Image size 2089x1764. Color fundus photograph: 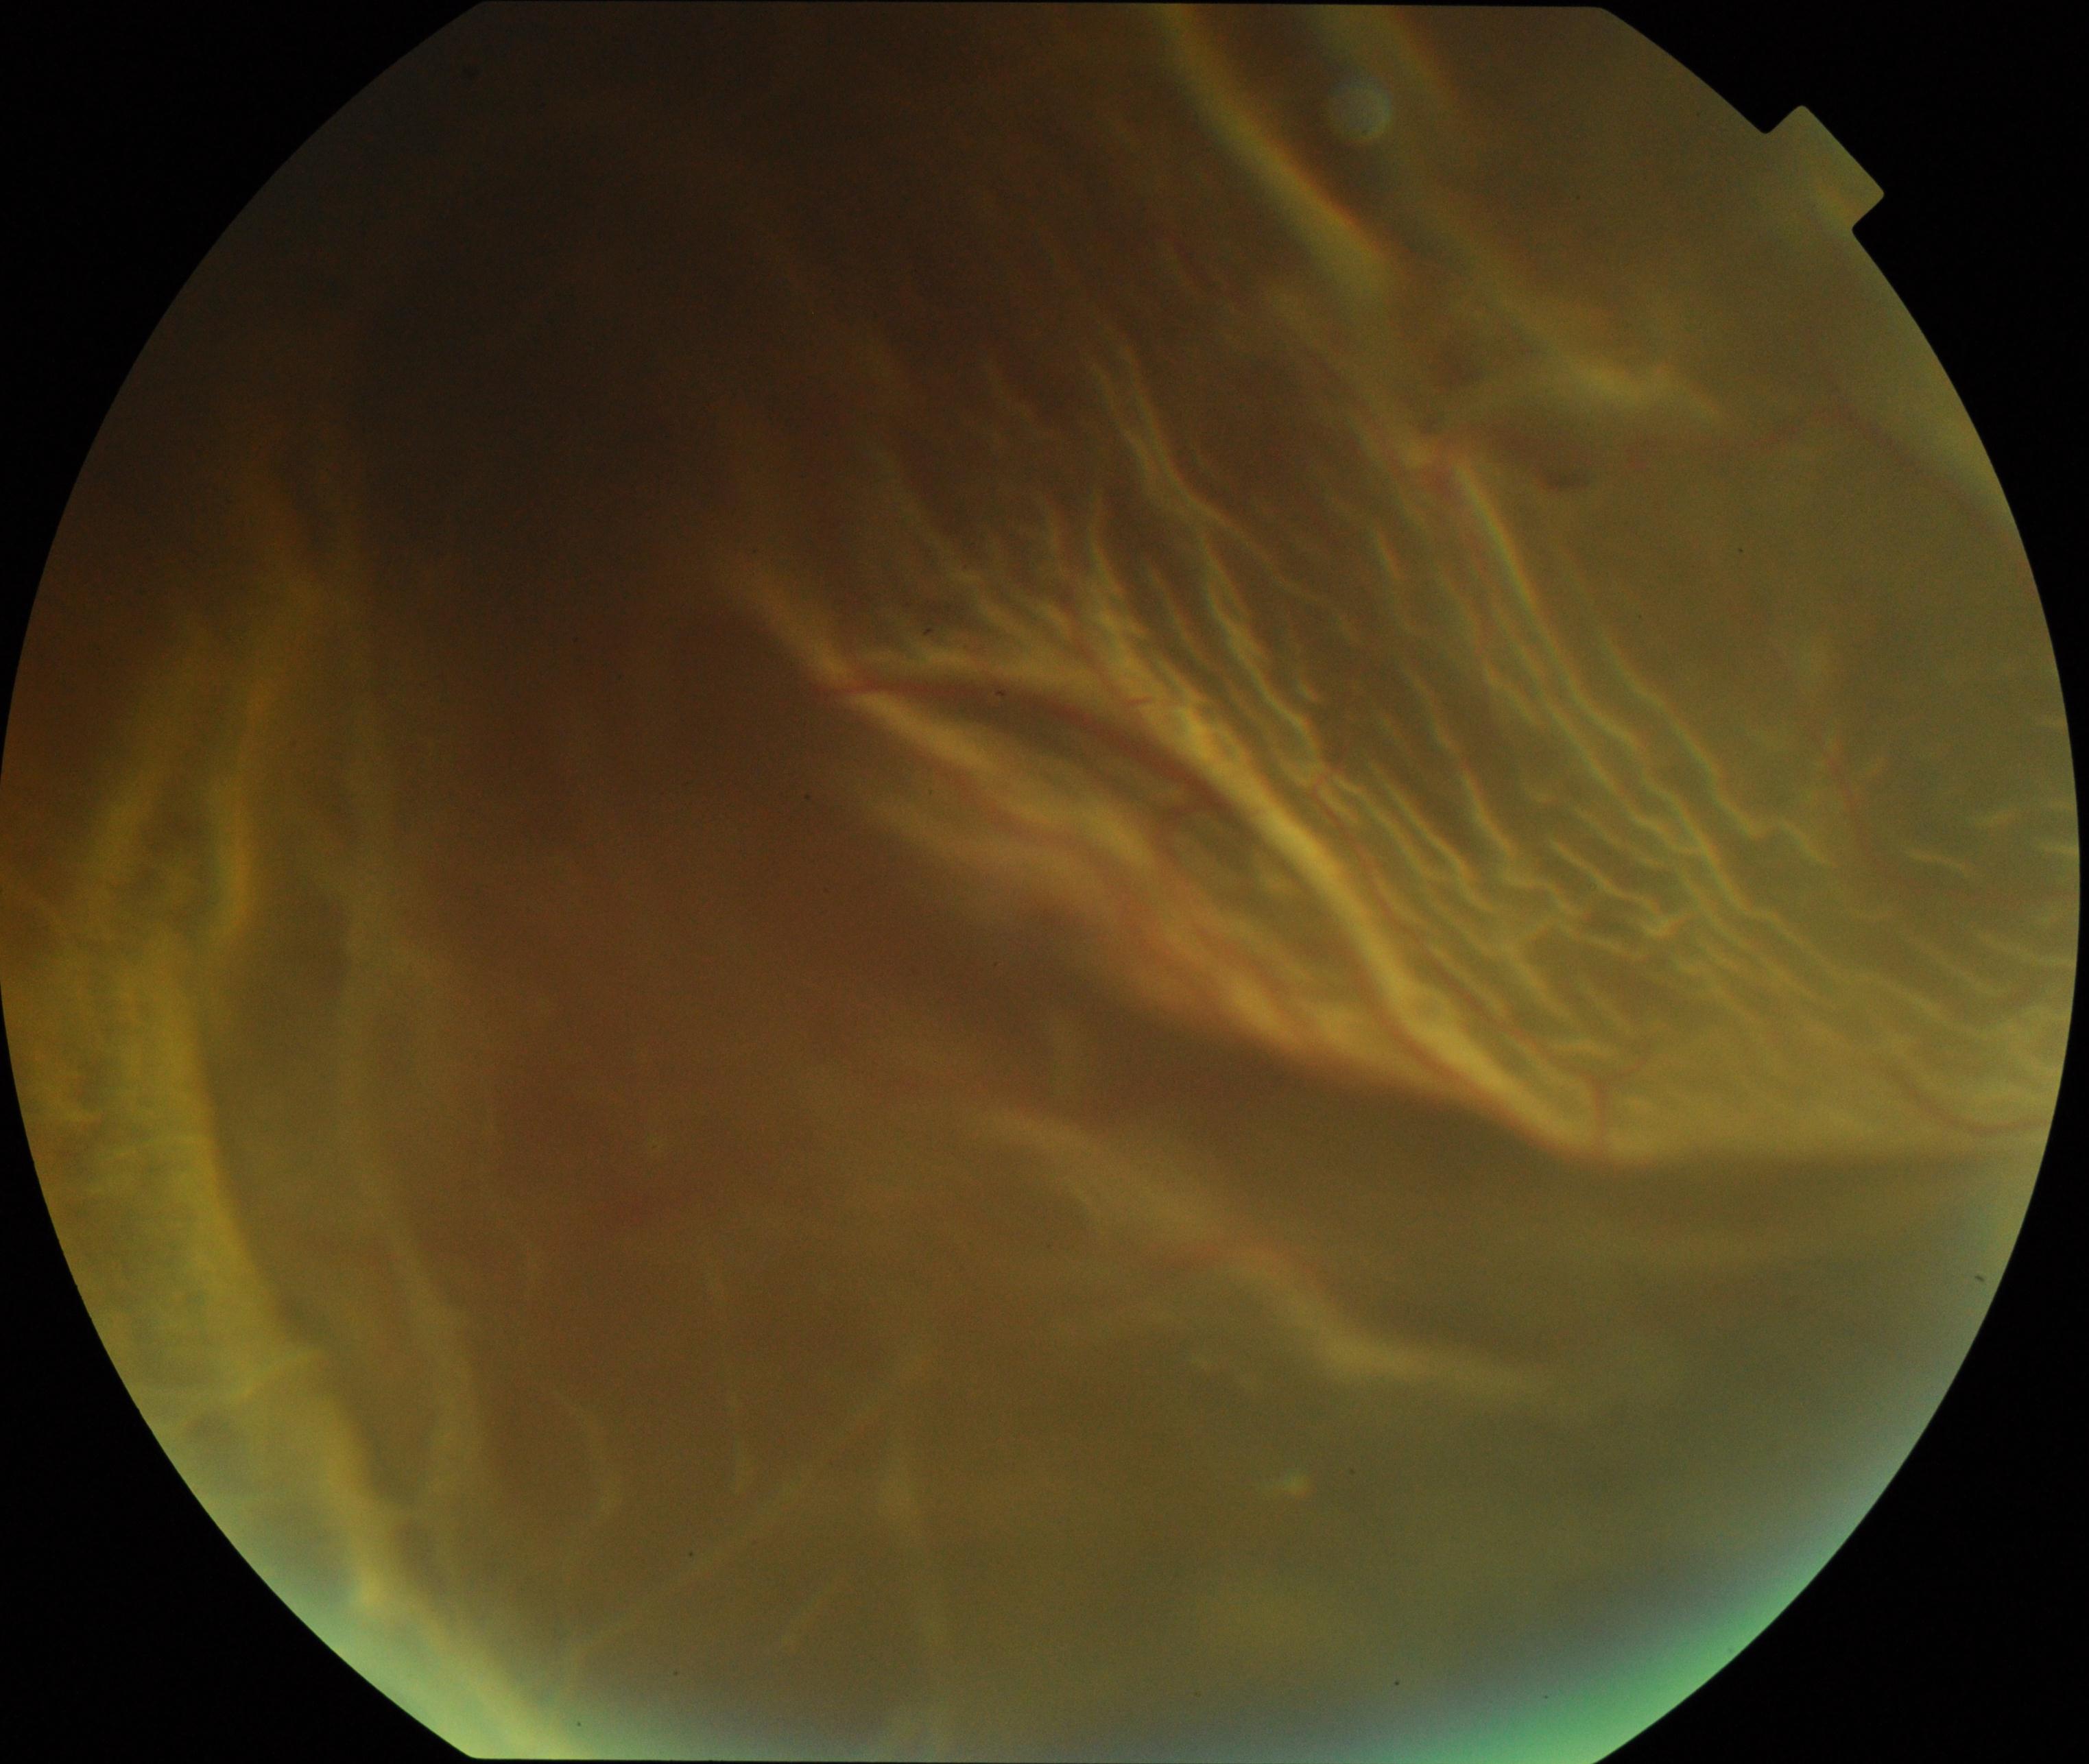

Classification: rhegmatogenous retinal detachment.